Wide-field fundus photograph from neonatal ROP screening
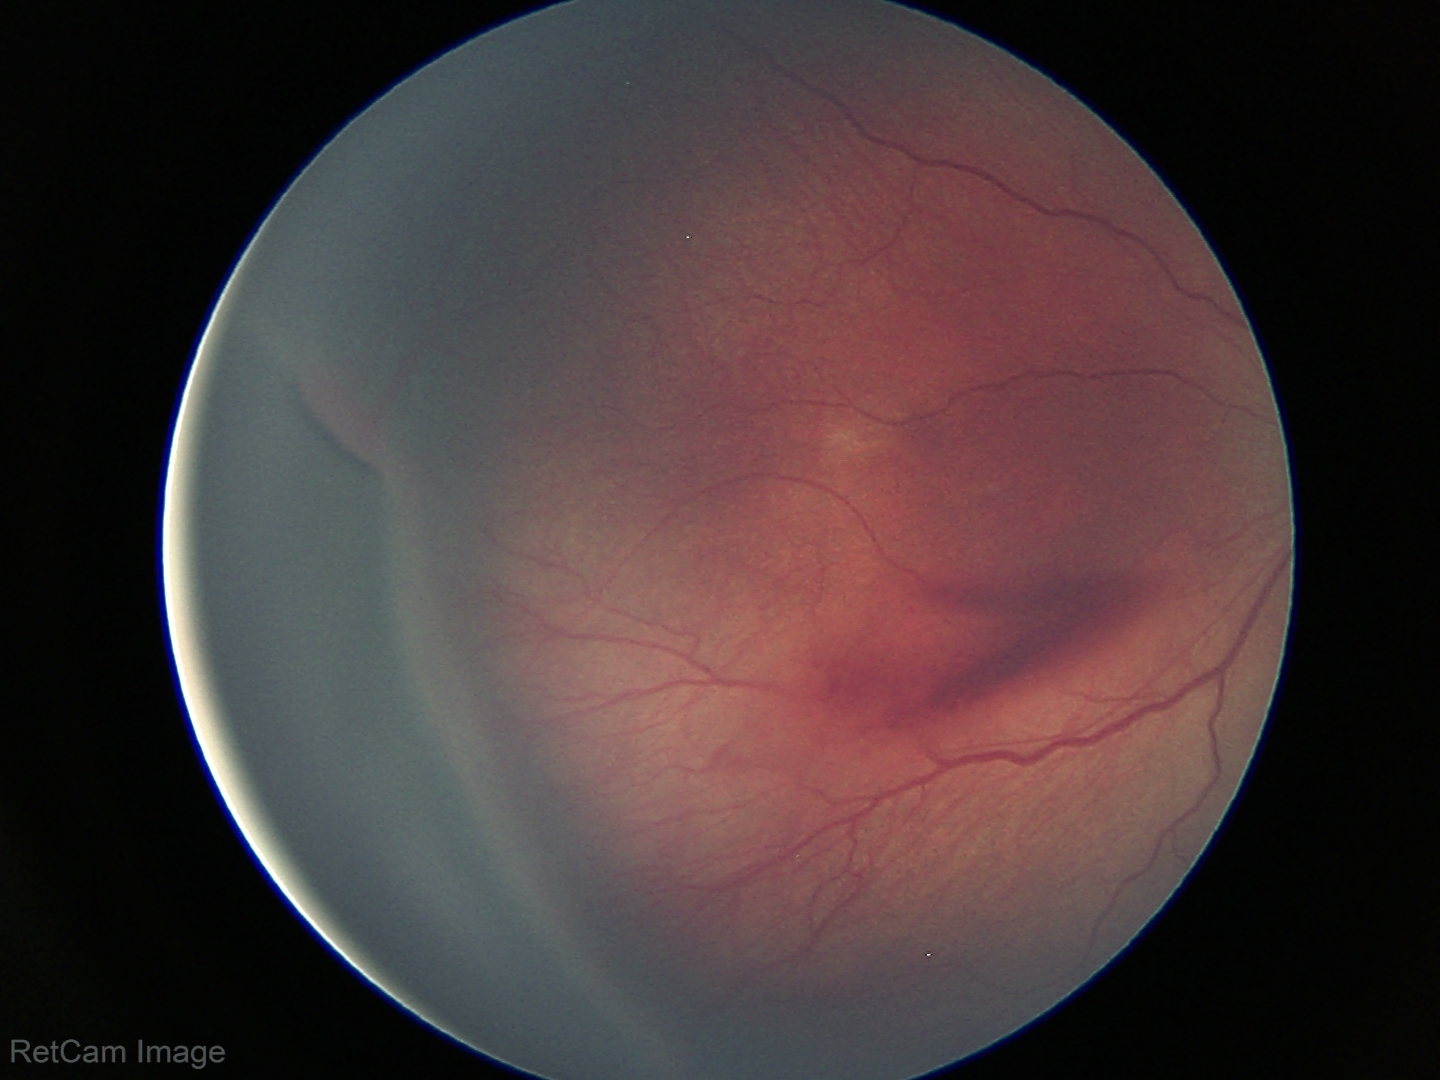
Without plus disease.
Series diagnosed as ROP stage 3.